Wide-field contact fundus photograph of an infant; captured with the Clarity RetCam 3 (130° field of view); 640x480: 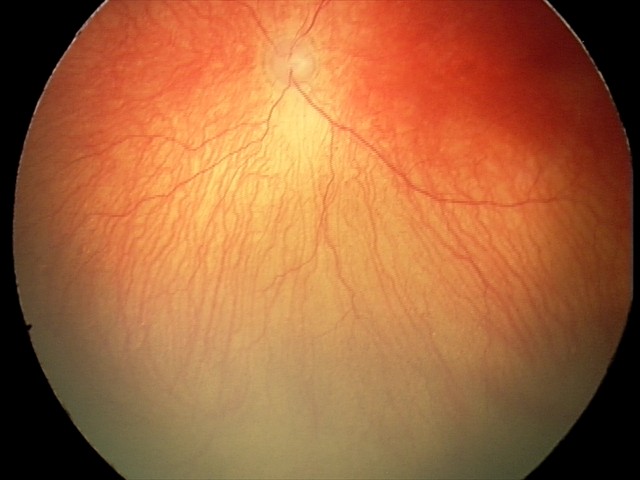 Finding = aggressive retinopathy of prematurity | plus form = present.